Infant wide-field fundus photograph
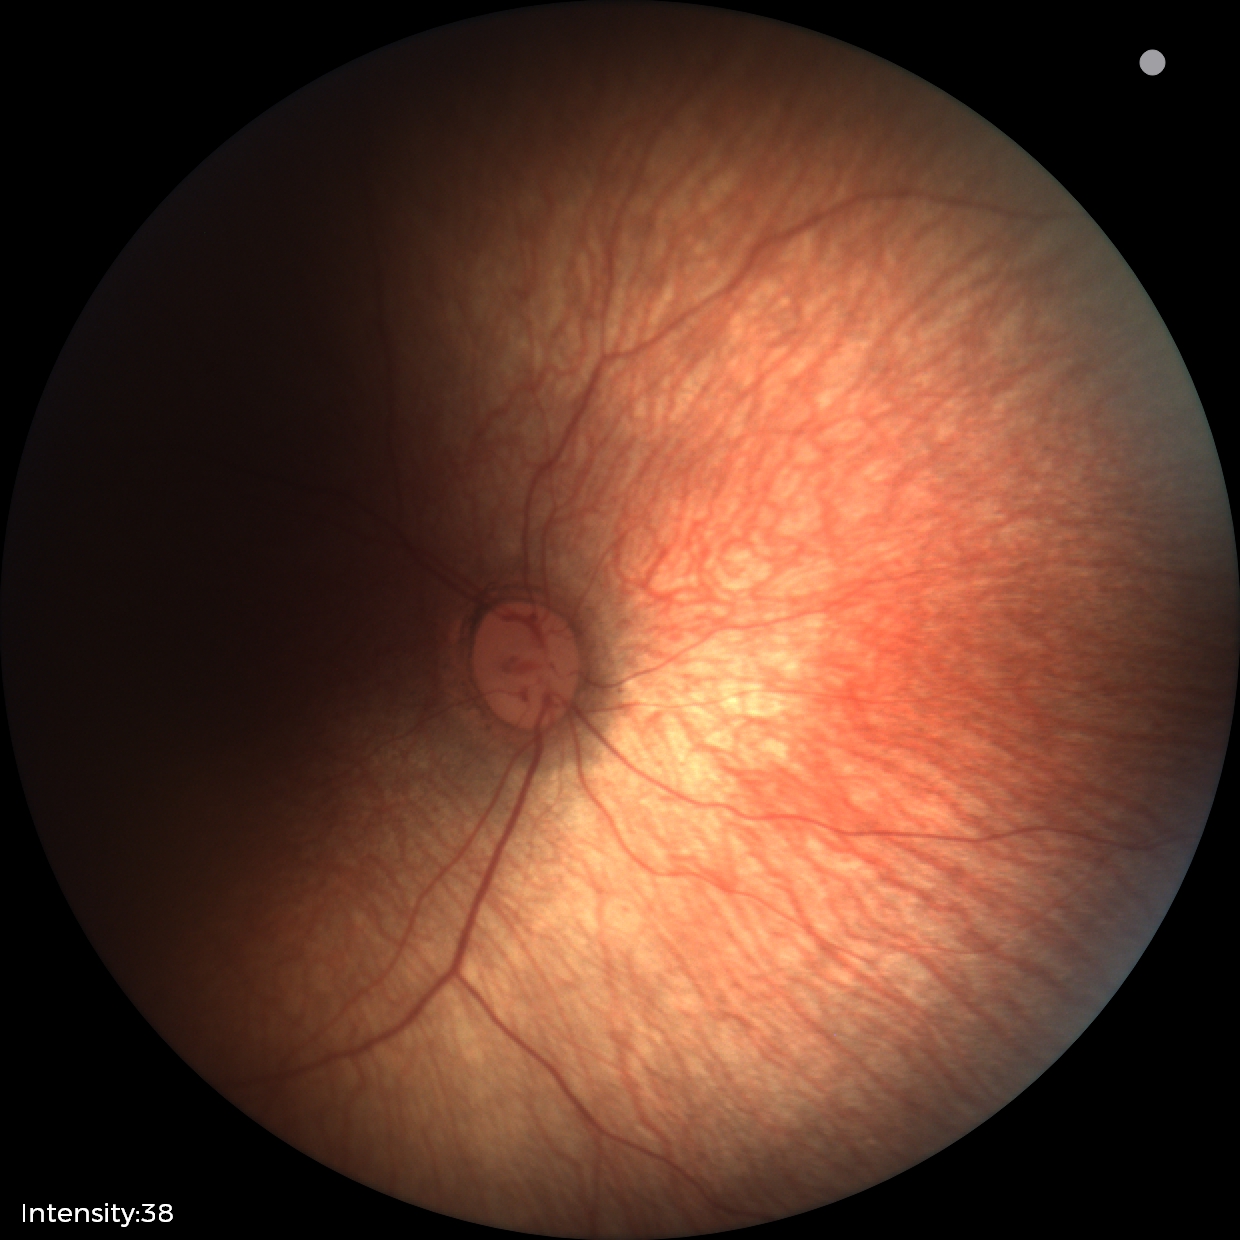
Screening examination with no abnormal retinal findings.